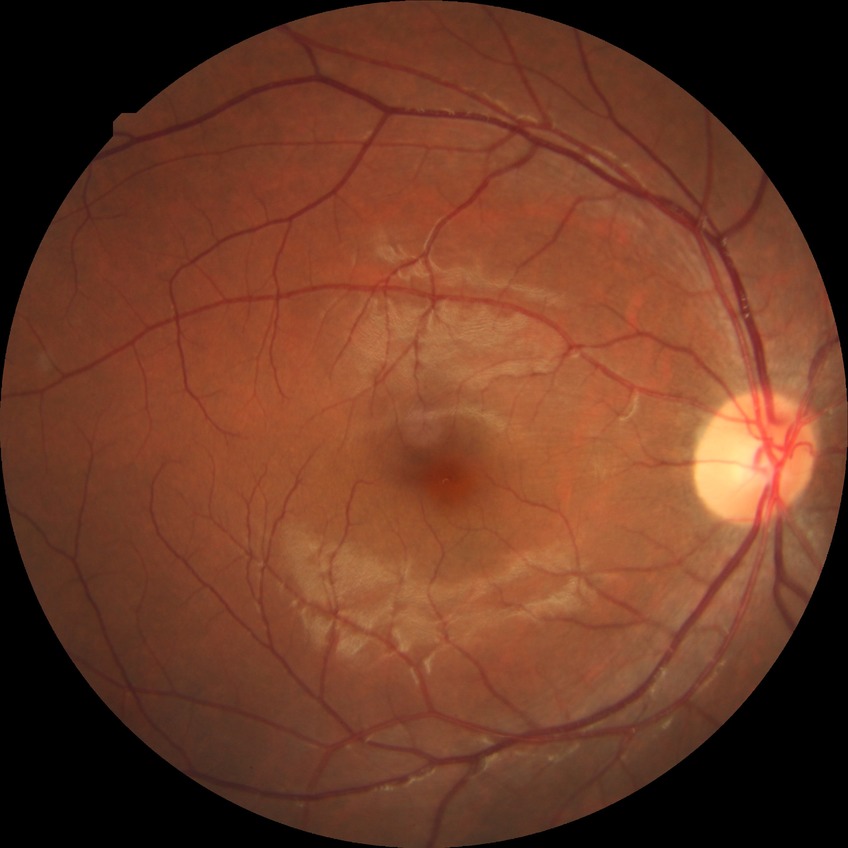 diabetic retinopathy (DR): NDR (no diabetic retinopathy).